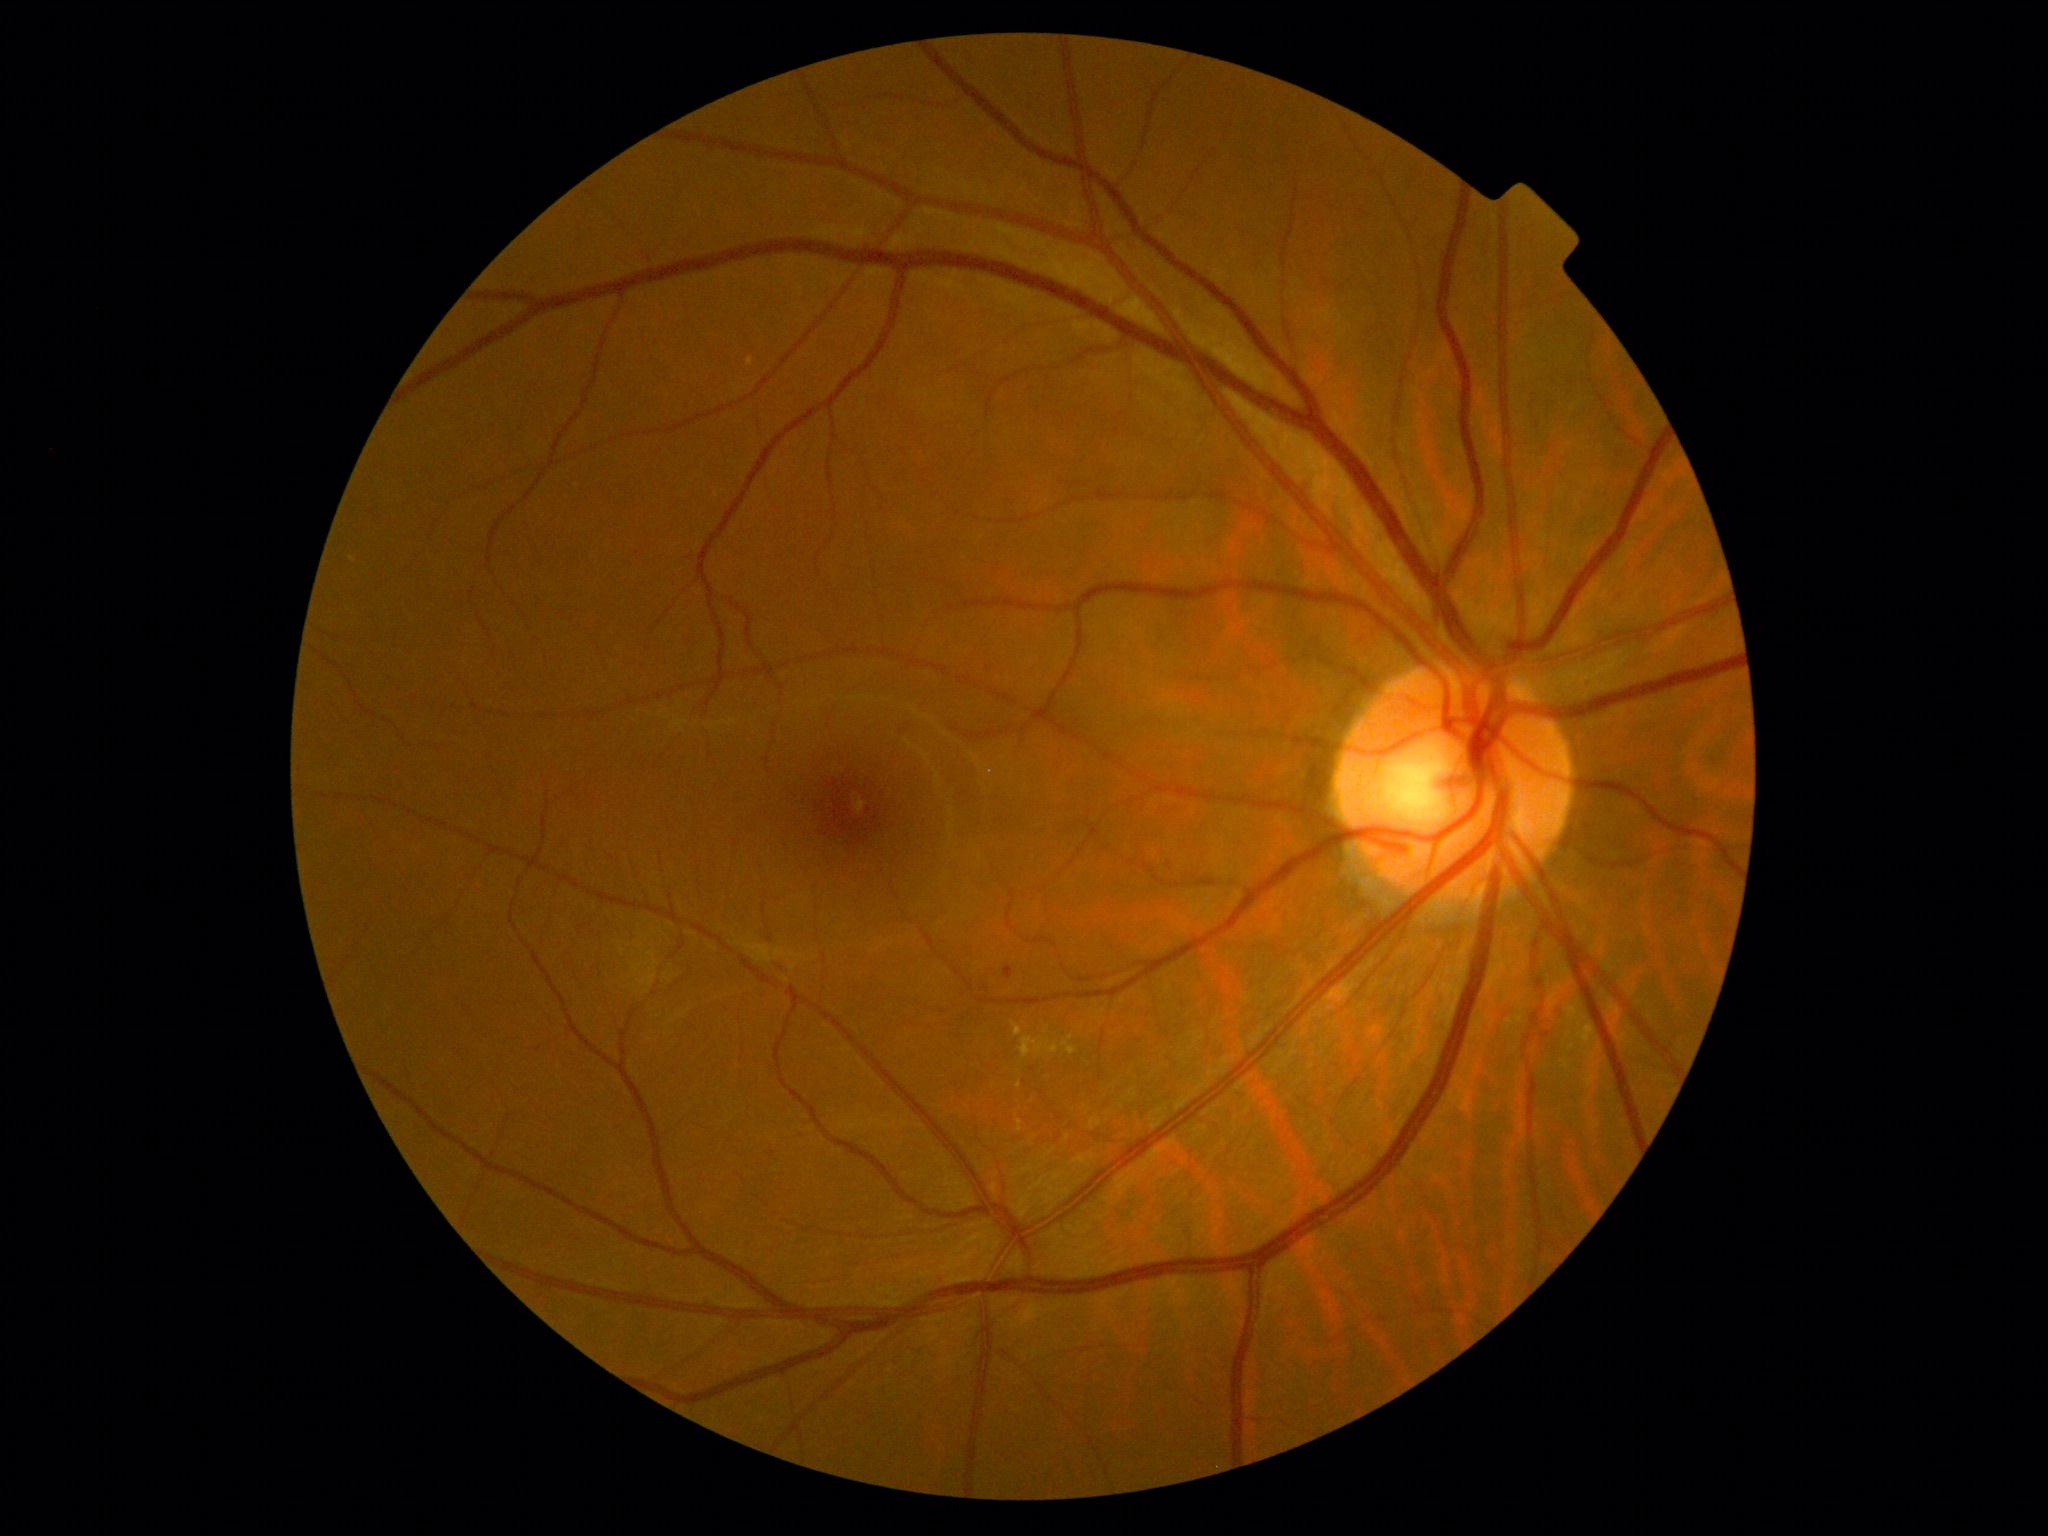

DR stage: 2.